No pharmacologic dilation · 848 by 848 pixels · camera: NIDEK AFC-230 · graded on the modified Davis scale · 45-degree field of view
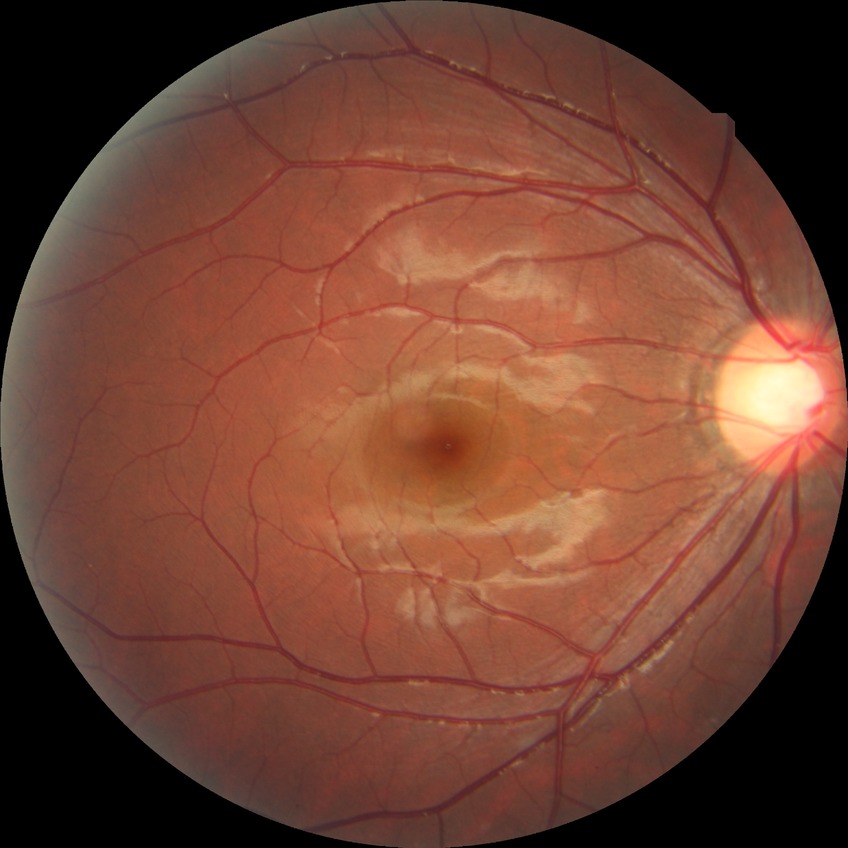

Diabetic retinopathy (DR) is no diabetic retinopathy (NDR).